Wide-field fundus photograph from neonatal ROP screening. 640x480px:
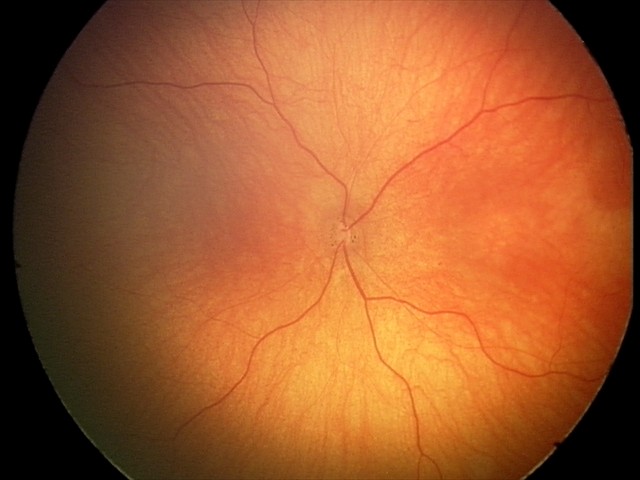

Diagnosis from this screening exam: optic nerve hypoplasia.